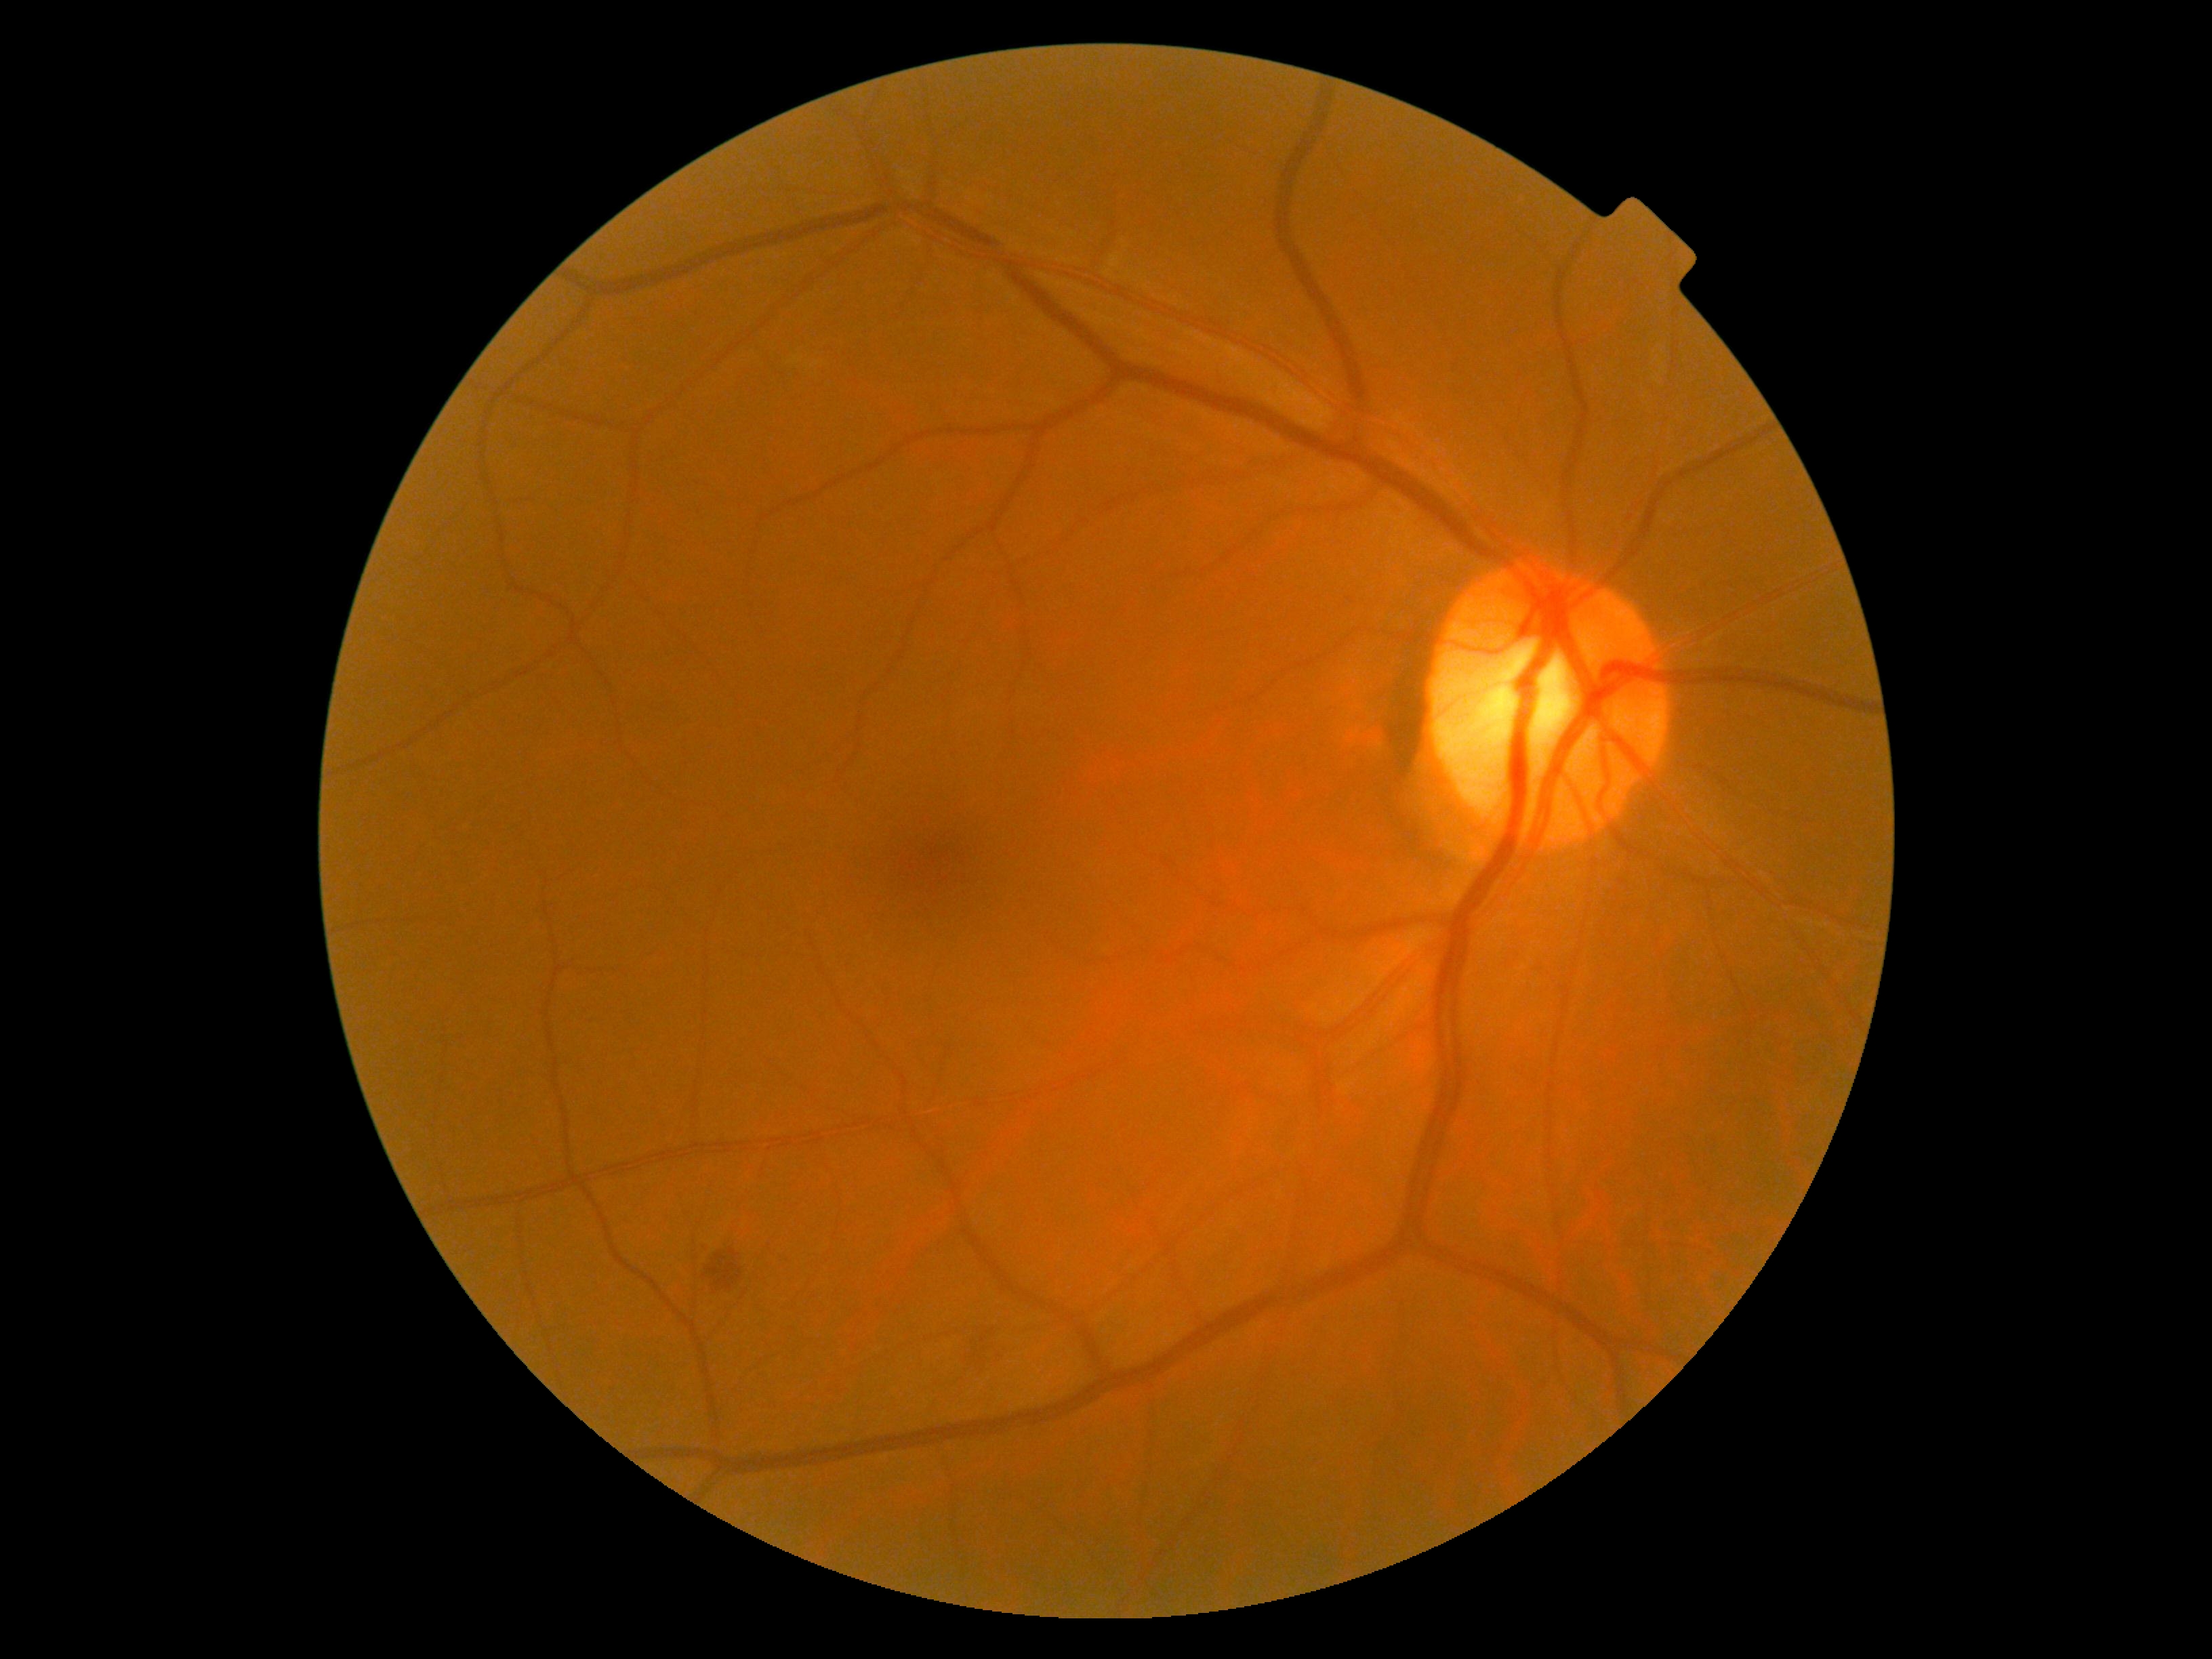

retinopathy=2.